Camera: NIDEK AFC-230, 848x848
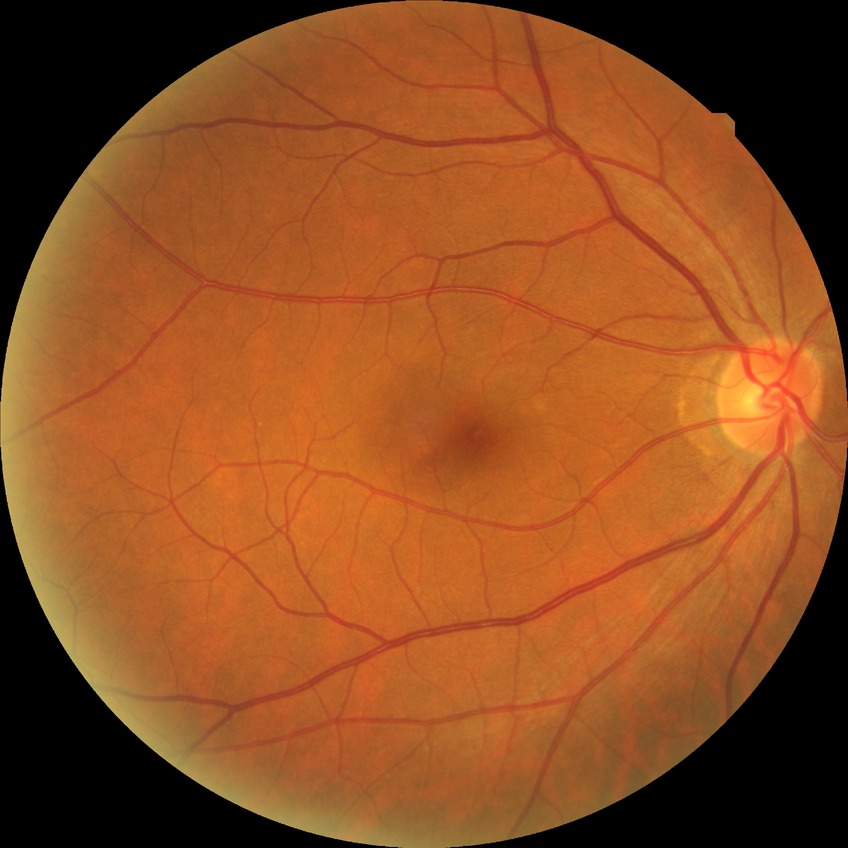

DR stage is NDR.
No diabetic retinal disease findings.